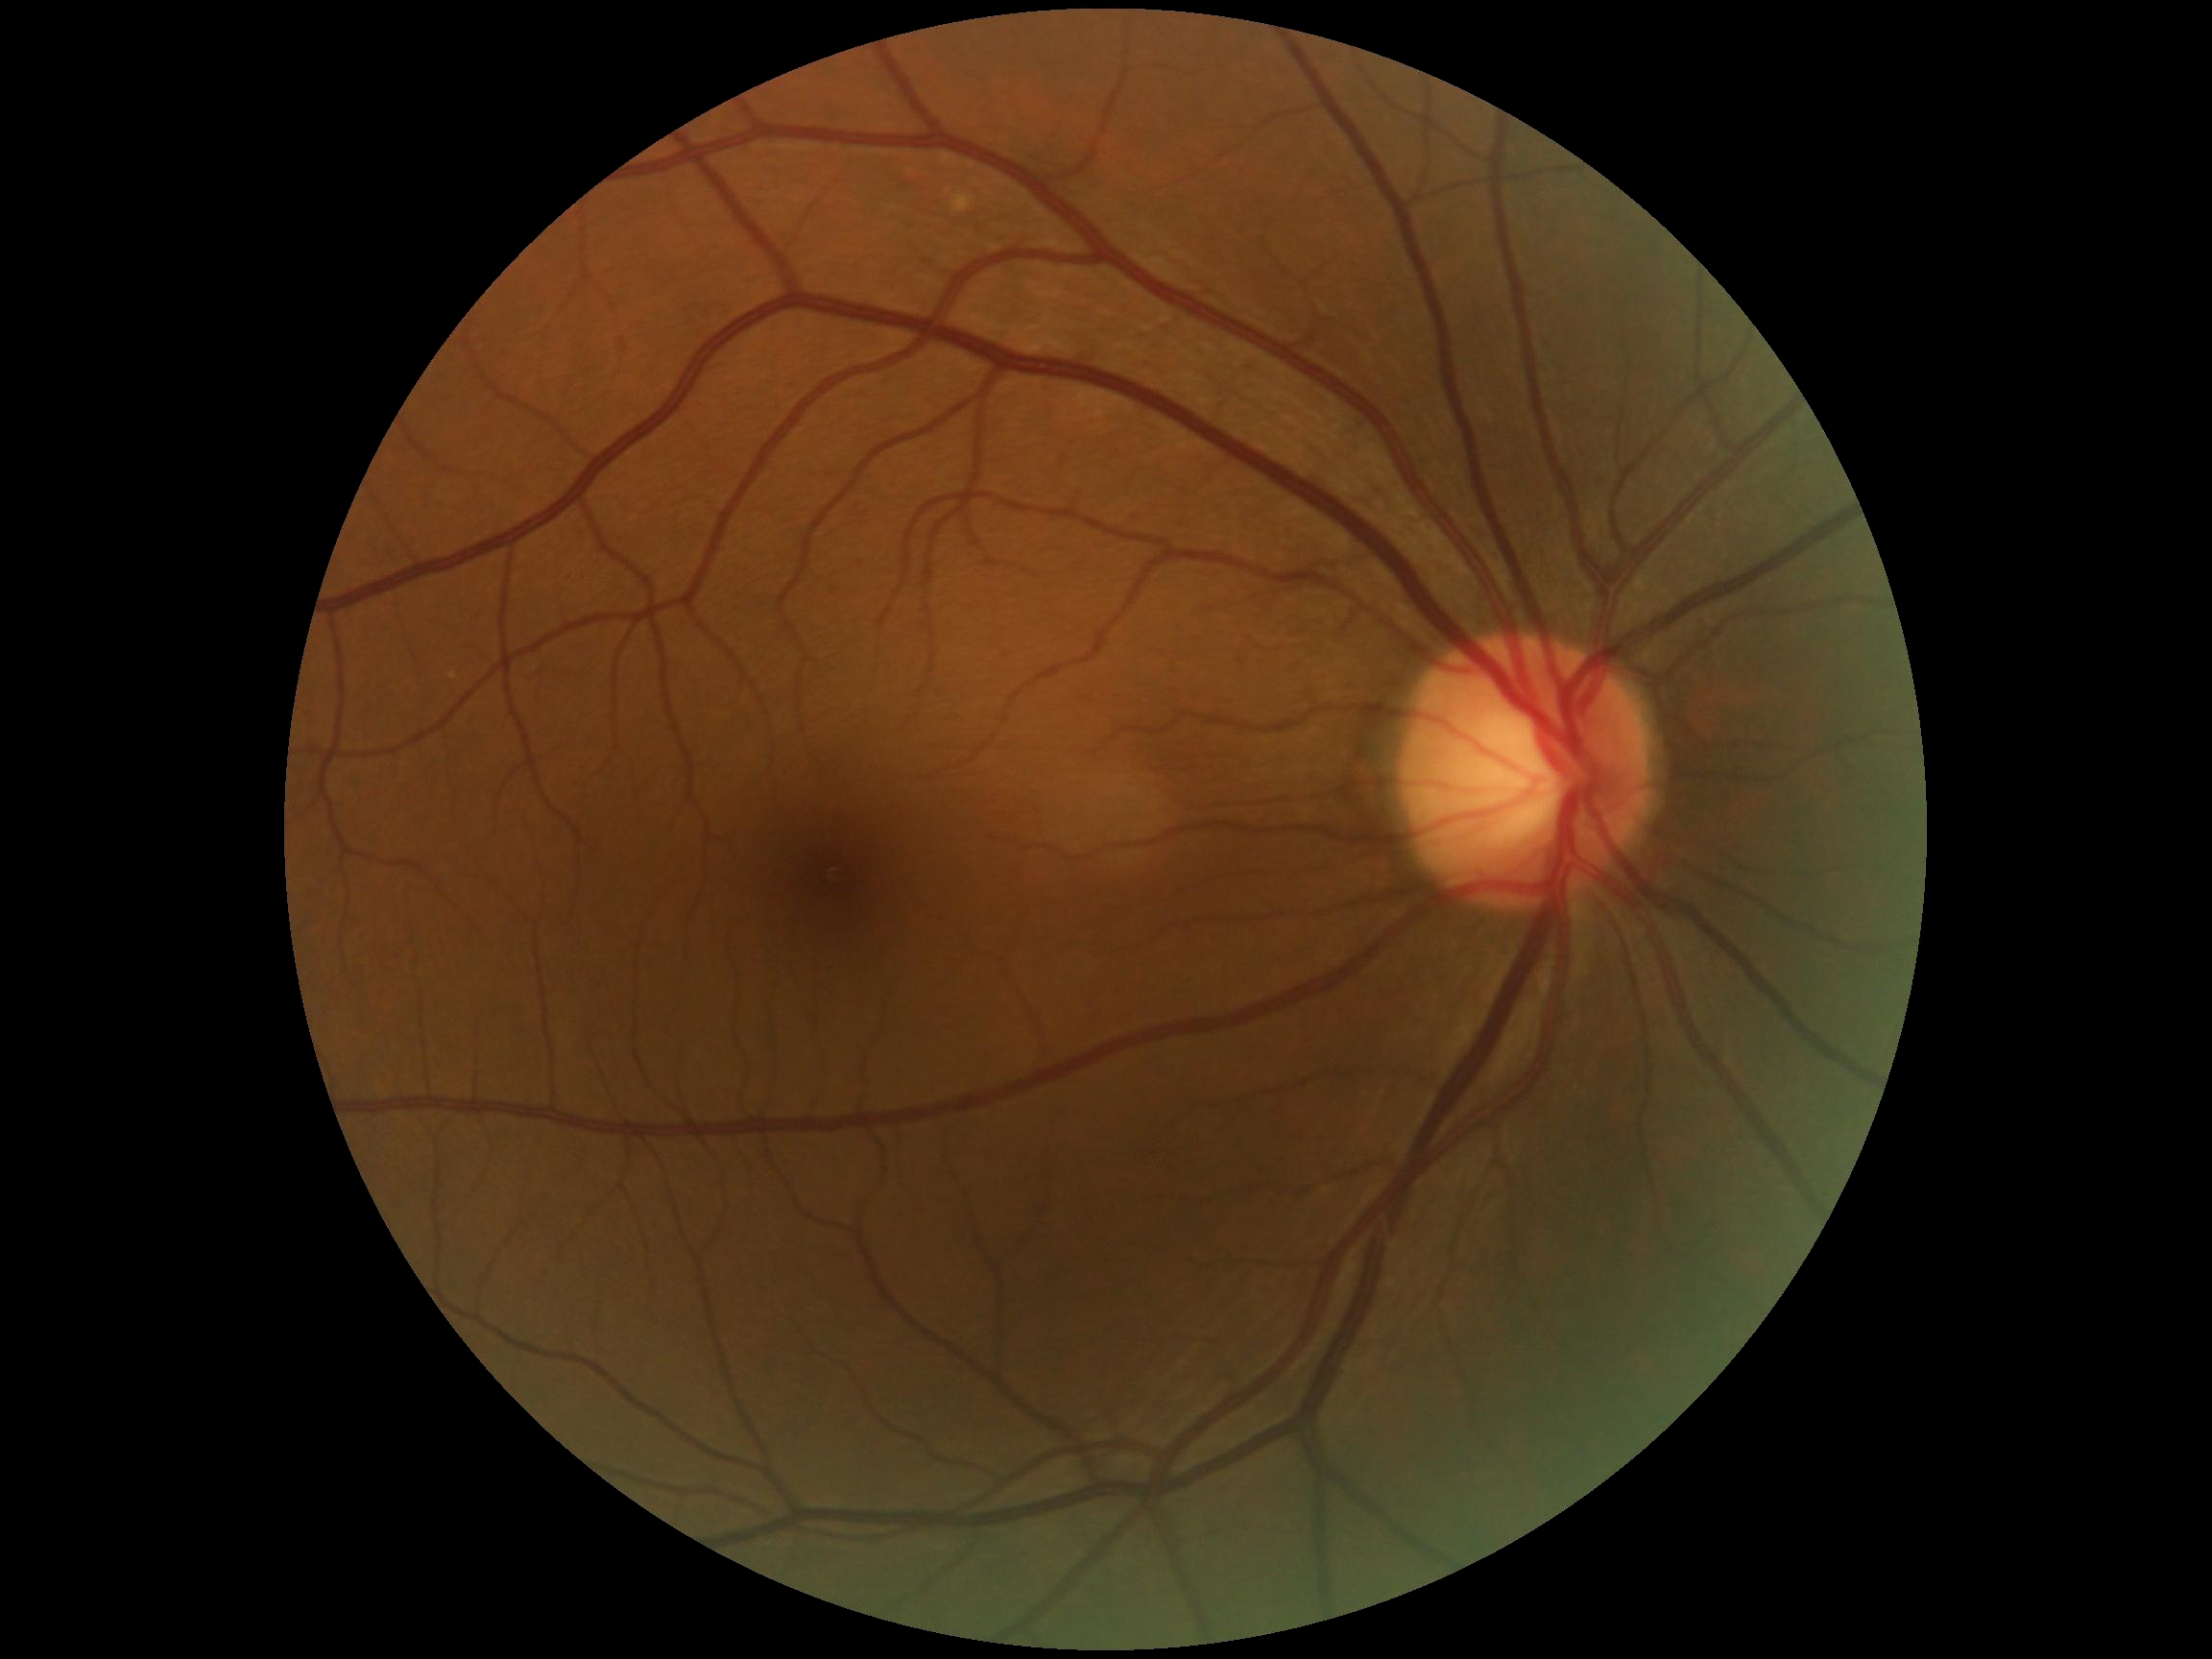 DR severity: grade 0 (no apparent retinopathy), DR impression: no apparent DR.